Modified Davis classification
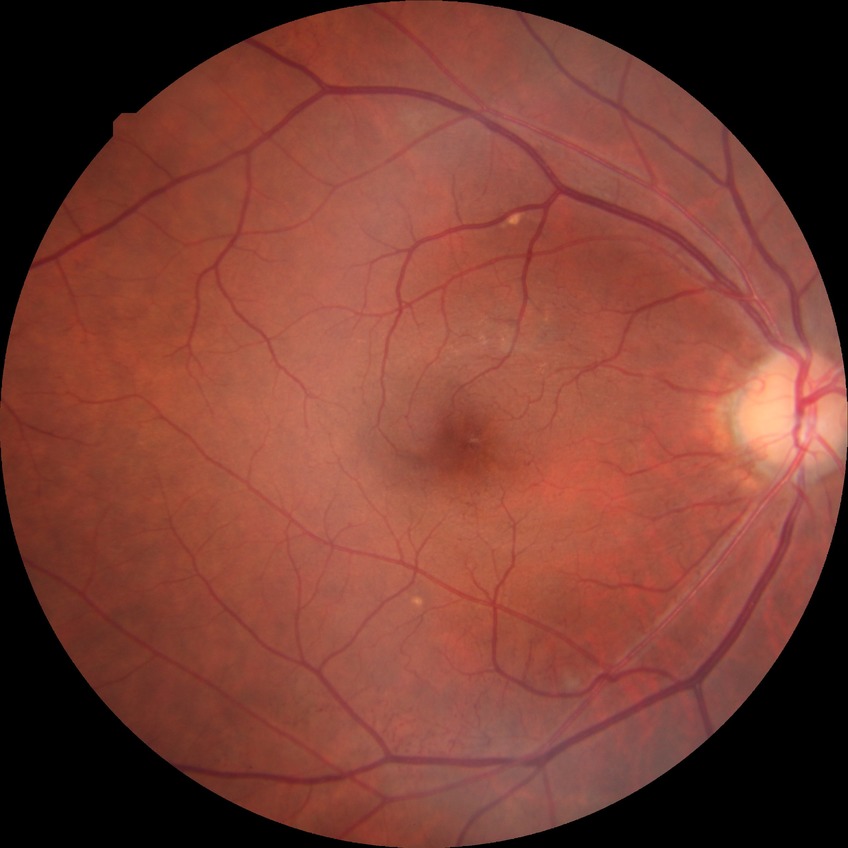

davis_grade: PPDR (pre-proliferative diabetic retinopathy)